45° field of view. 2212 x 1659 pixels.
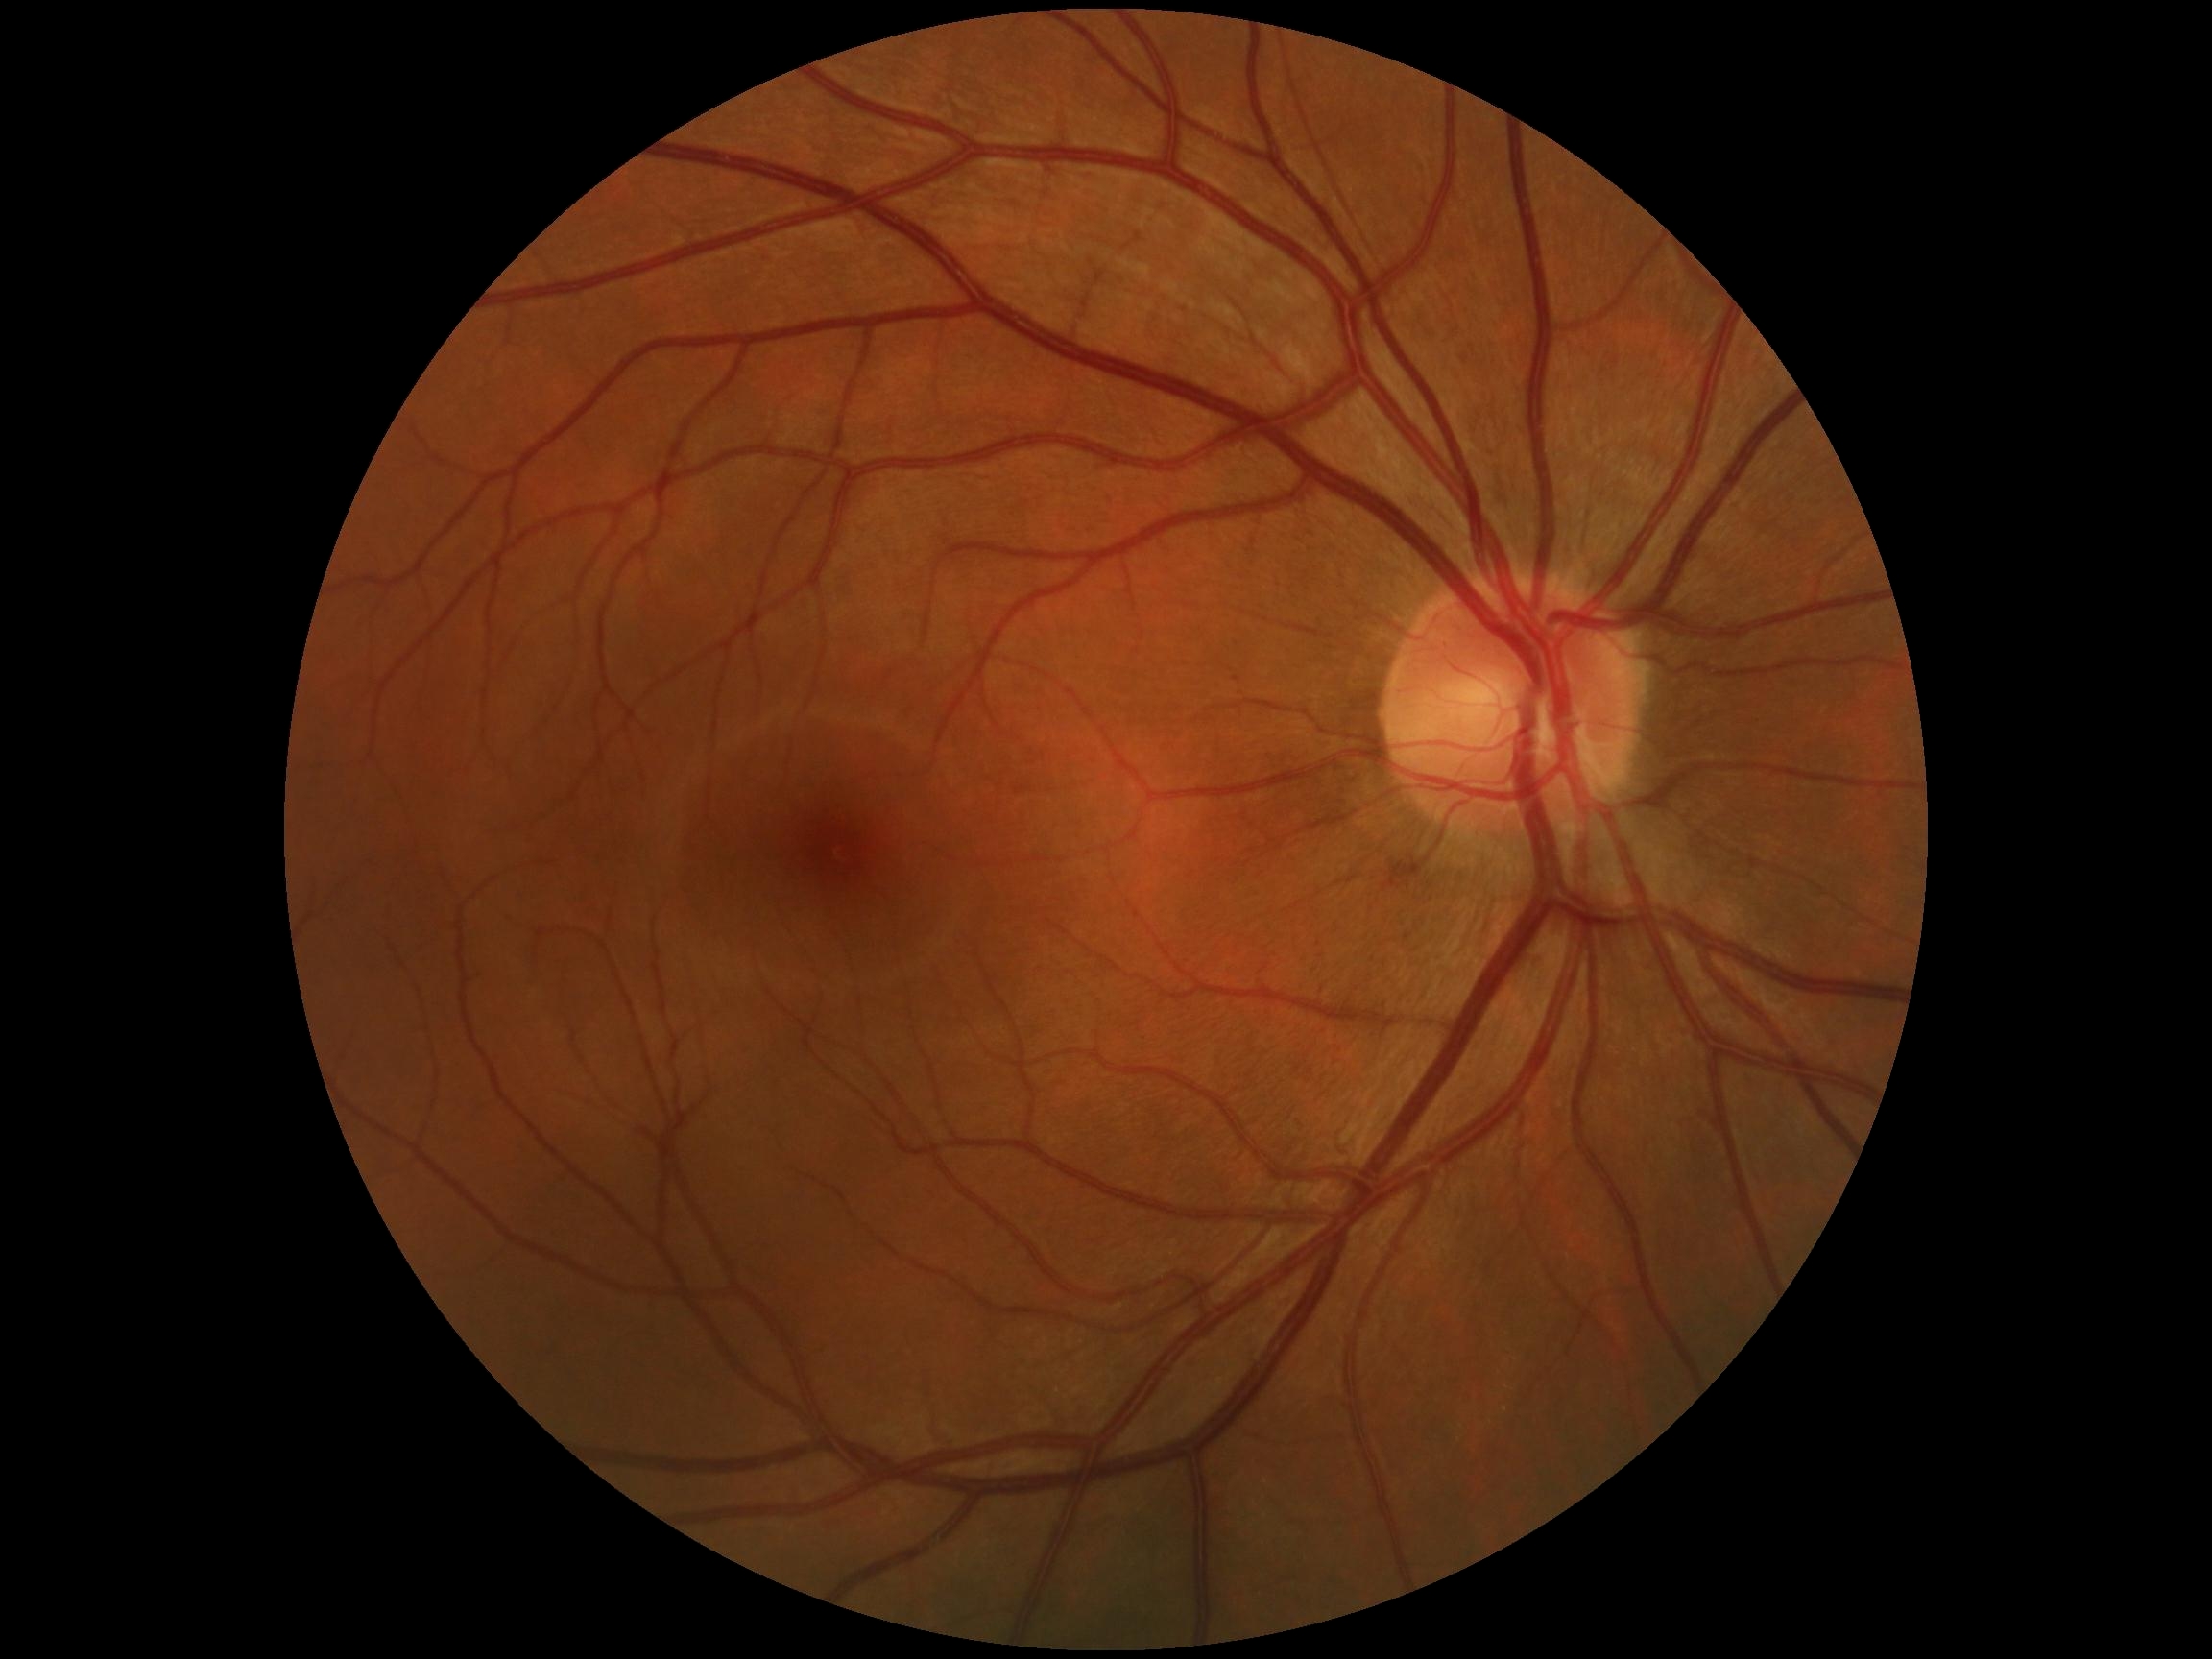
Diabetic retinopathy: 0/4.